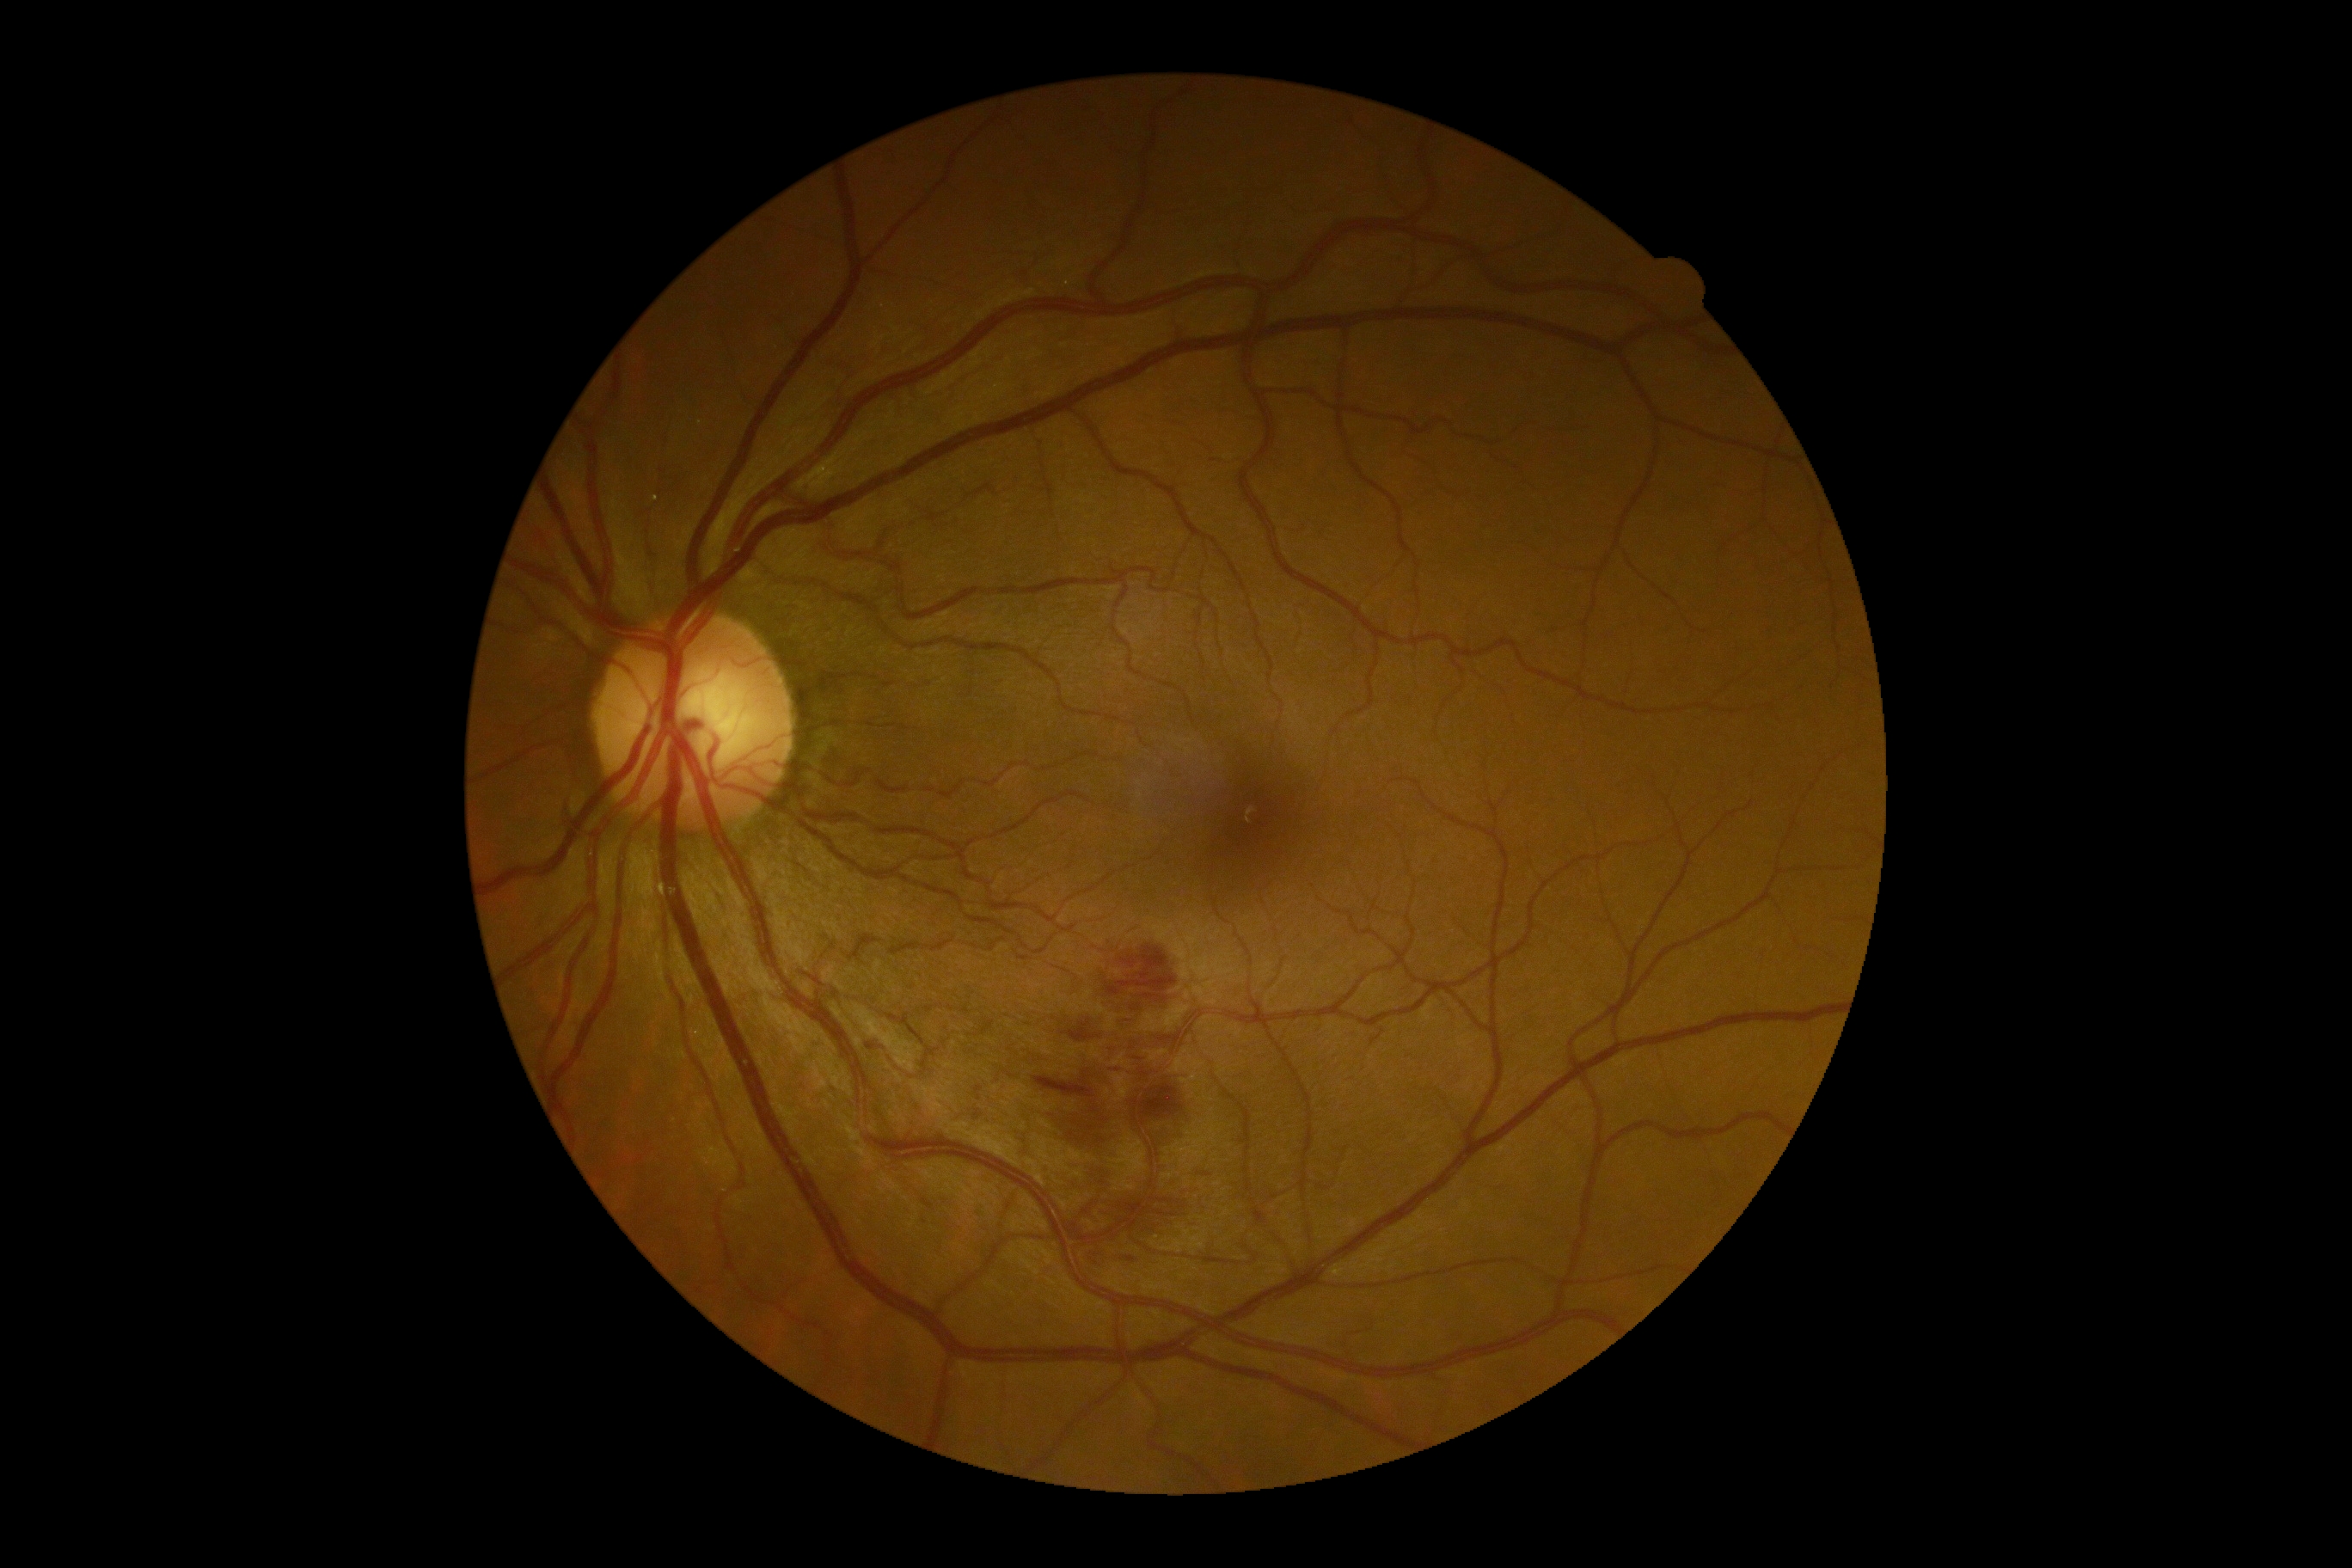
DR grade: 2 — more than just microaneurysms but less than severe NPDR.